2352 x 1568 pixels; 45° FOV; CFP: 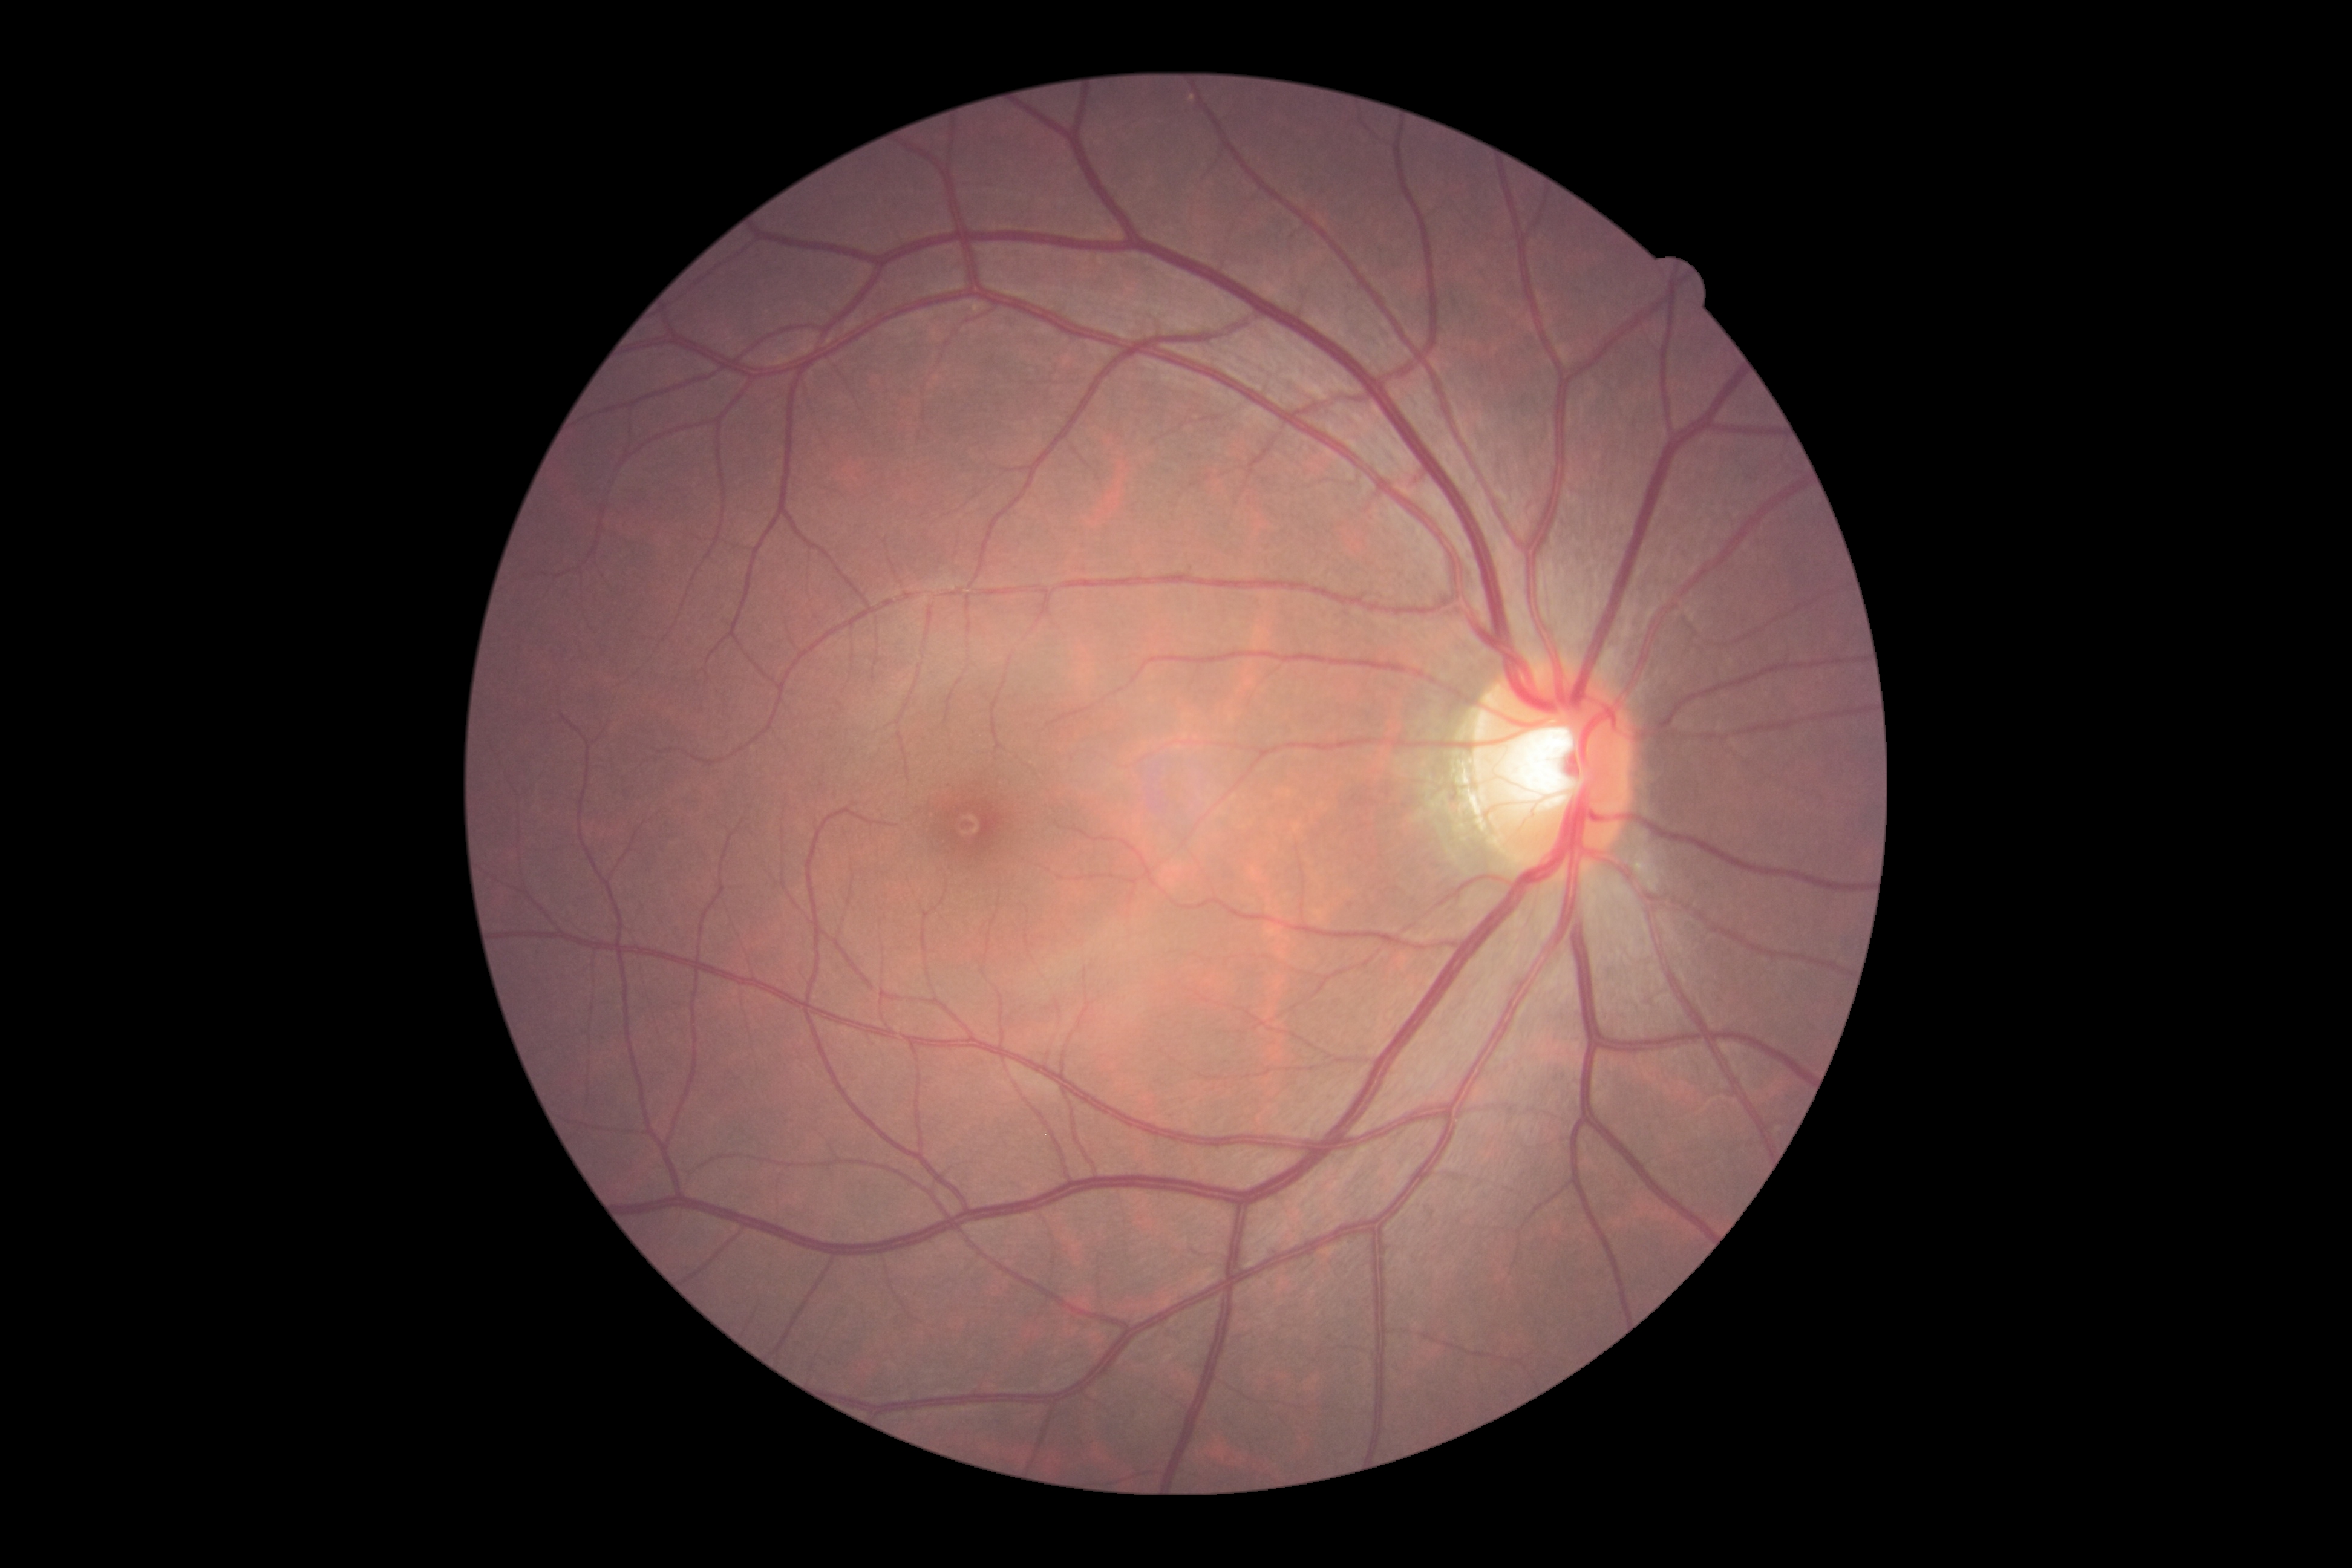 DR grade is no apparent retinopathy (0).
No apparent diabetic retinopathy.